Retinal fundus photograph.
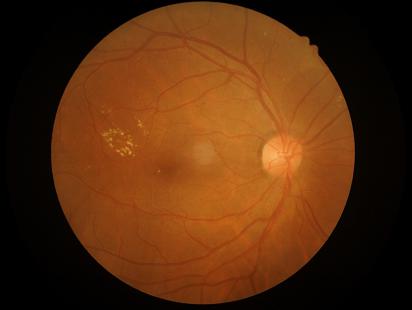 Overall image quality is good. No noticeable blur.